Infant wide-field retinal image. 1440x1080 — 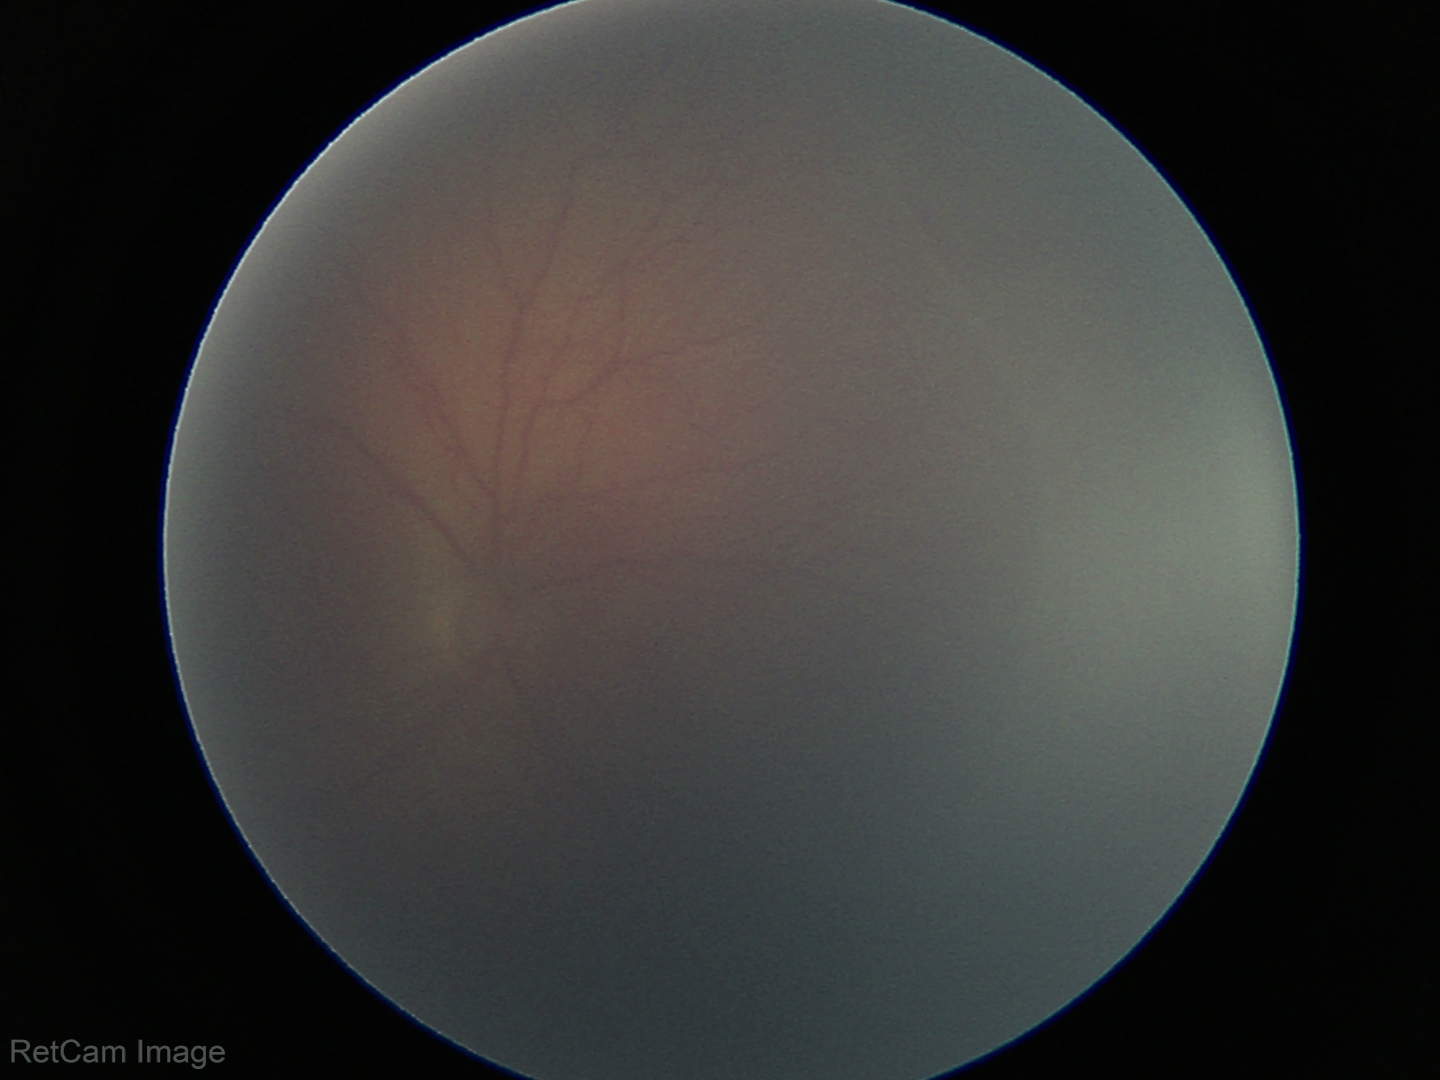 Plus disease absent. Diagnosis from this screening exam: ROP stage 2.